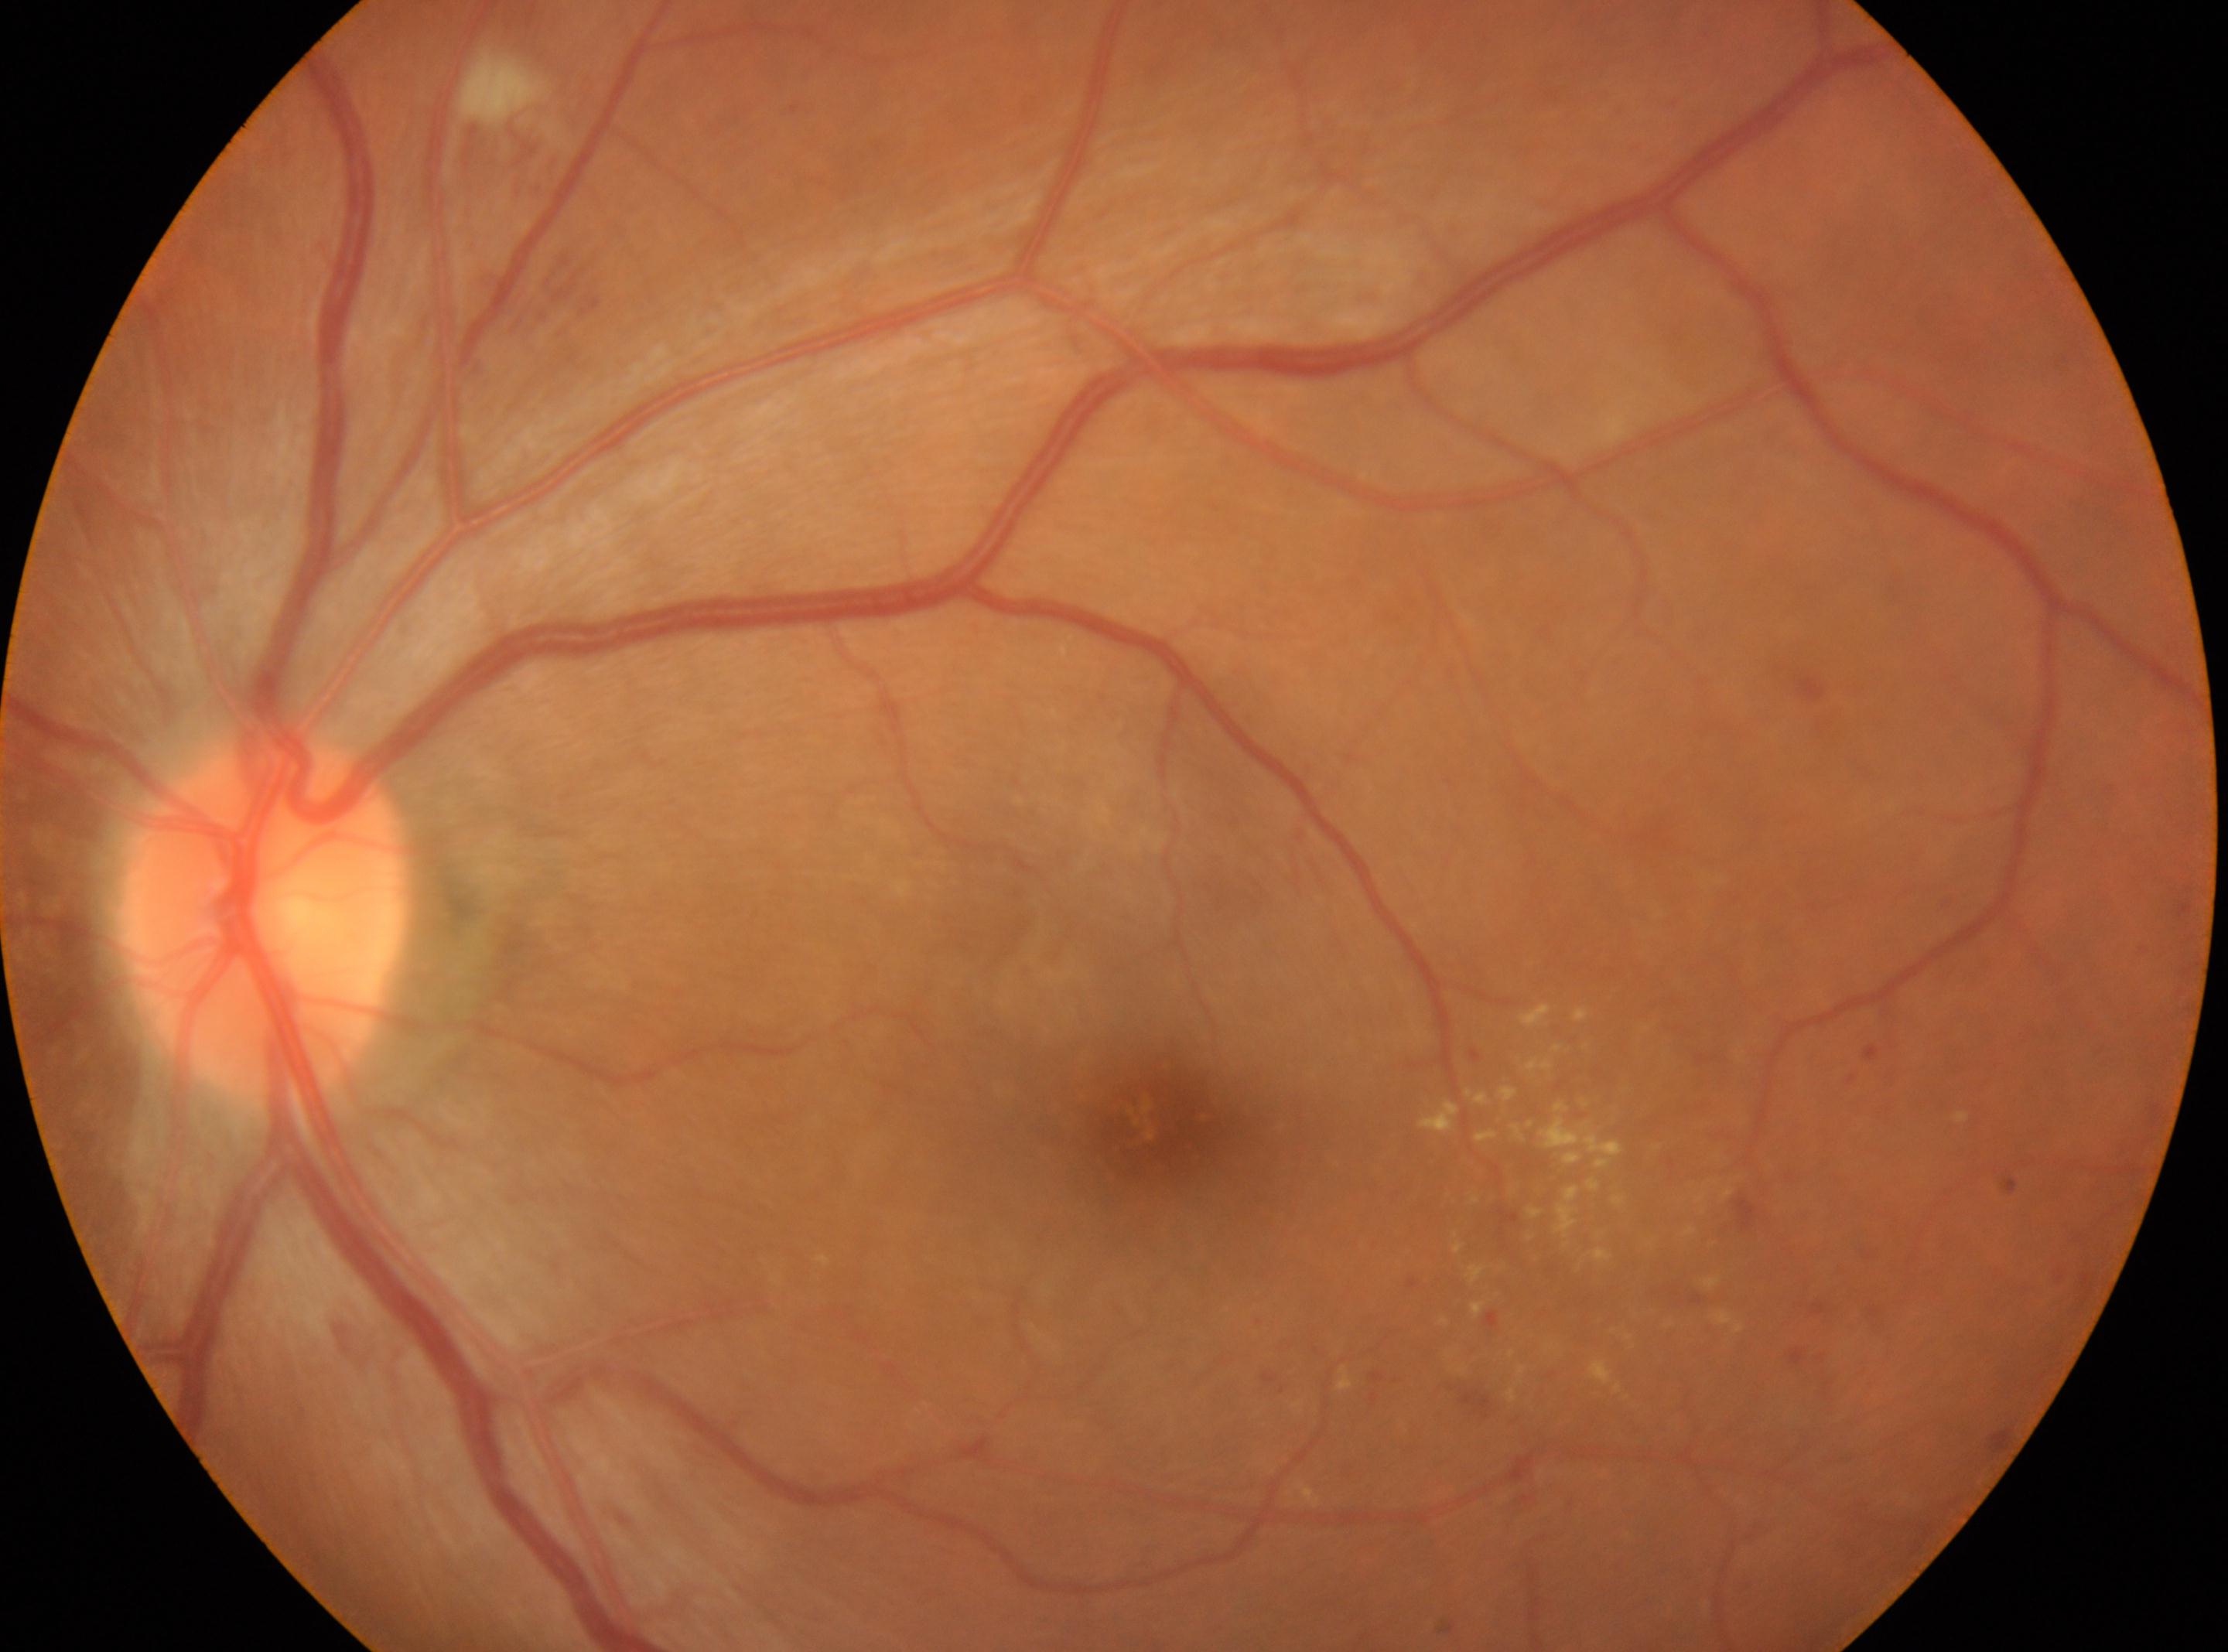 Macular center located at 1156, 1132.
Diabetic retinopathy (DR): moderate NPDR (grade 2).
The disc center is at 262, 920.
DR class: non-proliferative diabetic retinopathy.
This is the left eye.